848 x 848 pixels. Posterior pole photograph. 45° field of view. Nonmydriatic fundus photograph — 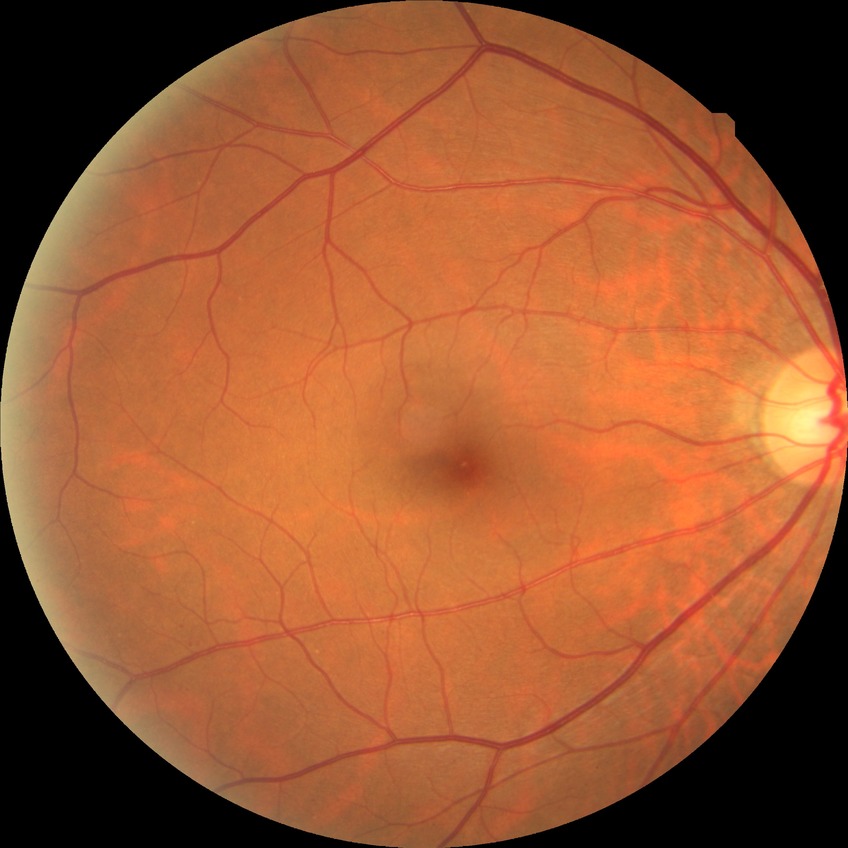
diabetic retinopathy (DR): NDR (no diabetic retinopathy).